2352x1568px, 45° field of view
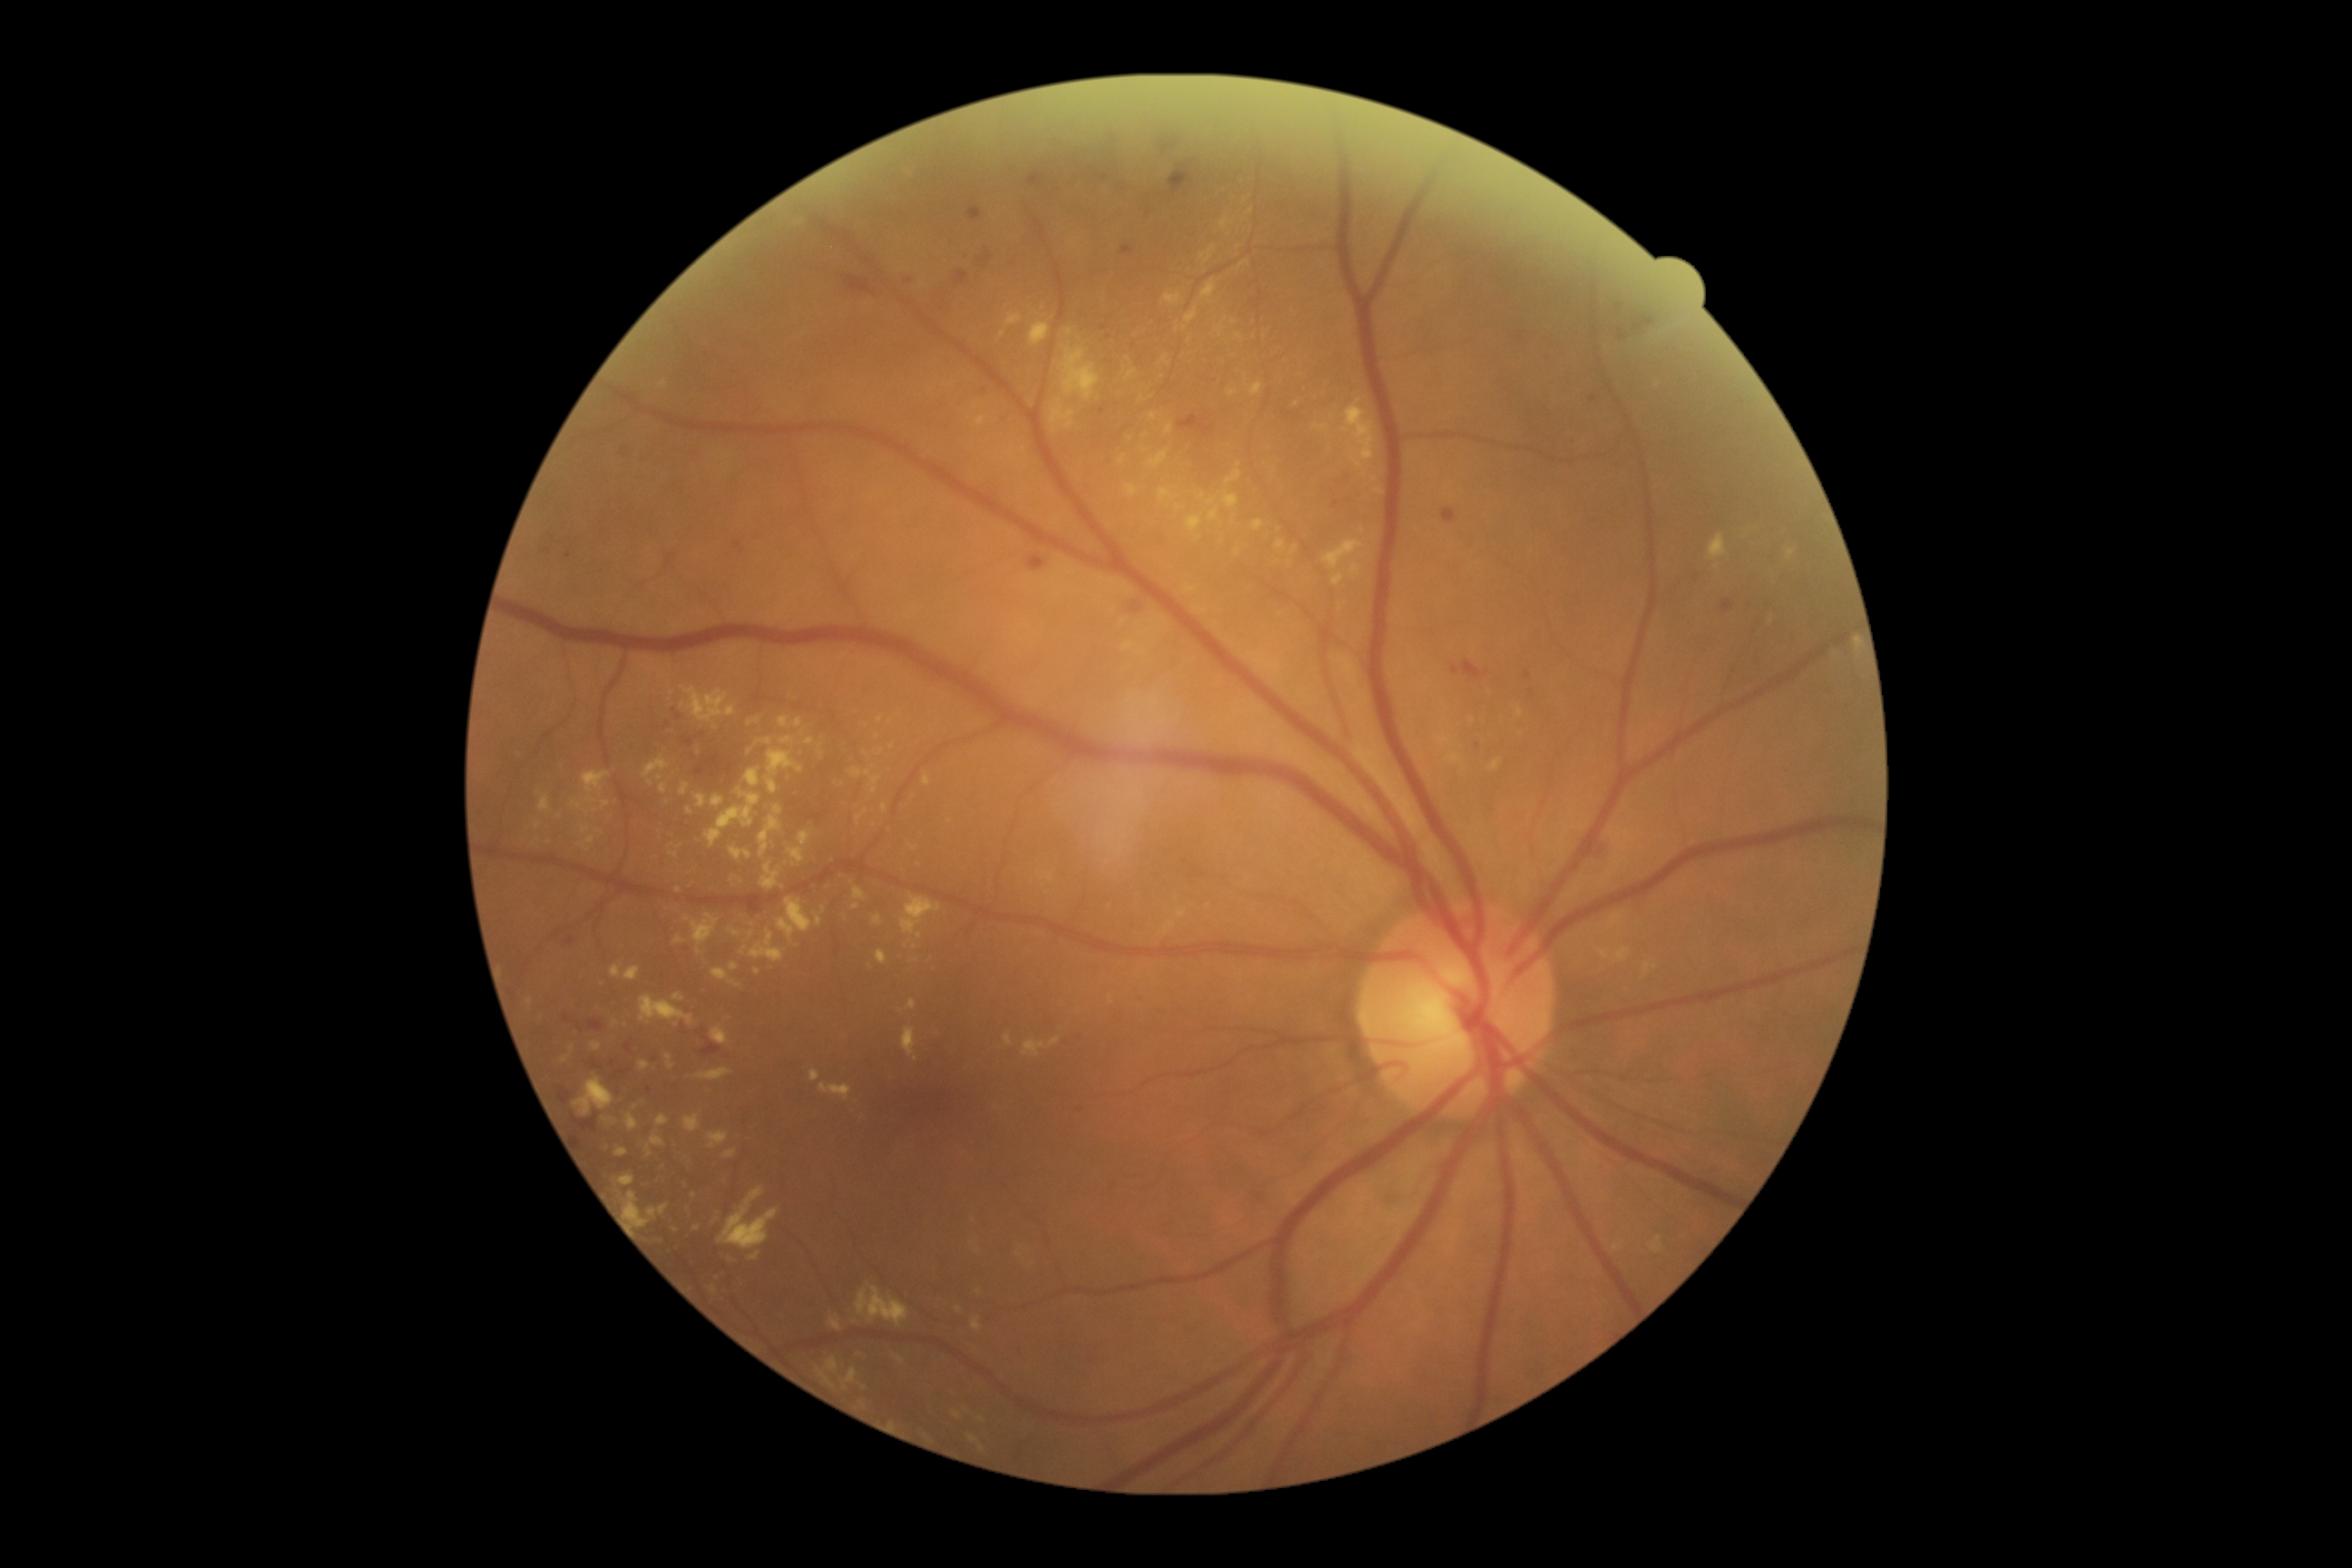

Diabetic retinopathy (DR): 2
Selected lesions:
hard exudates (EXs) (subset): 1250 382 1264 397; 729 928 740 937; 1436 734 1451 745; 705 789 761 848; 1110 995 1113 1004; 1625 948 1631 963; 660 783 667 796; 750 930 785 963; 1220 219 1235 231; 1030 322 1050 346; 1342 322 1351 337; 1200 246 1217 262
Smaller EXs around [542, 641]; [1185, 329]; [585, 830]; [914, 849]; [679, 891]; [859, 1356]; [1238, 248]
microaneurysms (MAs) (subset): 549 534 556 544; 609 1070 631 1083; 1524 671 1533 681; 542 549 553 556; 607 1061 616 1068; 734 540 745 554; 1529 689 1534 698; 1128 602 1144 614
Smaller MAs around [627, 1164]; [656, 1060]; [650, 1090]
hemorrhages (HEs) (subset): 752 899 769 912; 564 1014 573 1023; 977 250 992 270; 841 273 876 297; 587 1019 605 1032; 1612 302 1656 335; 1451 660 1491 683; 1028 554 1048 573; 681 736 694 747; 1177 411 1217 442; 966 201 983 220
Smaller HEs around [908, 282]; [1122, 187]; [675, 711]